CFP. 45° field of view. 2184 x 1690 pixels
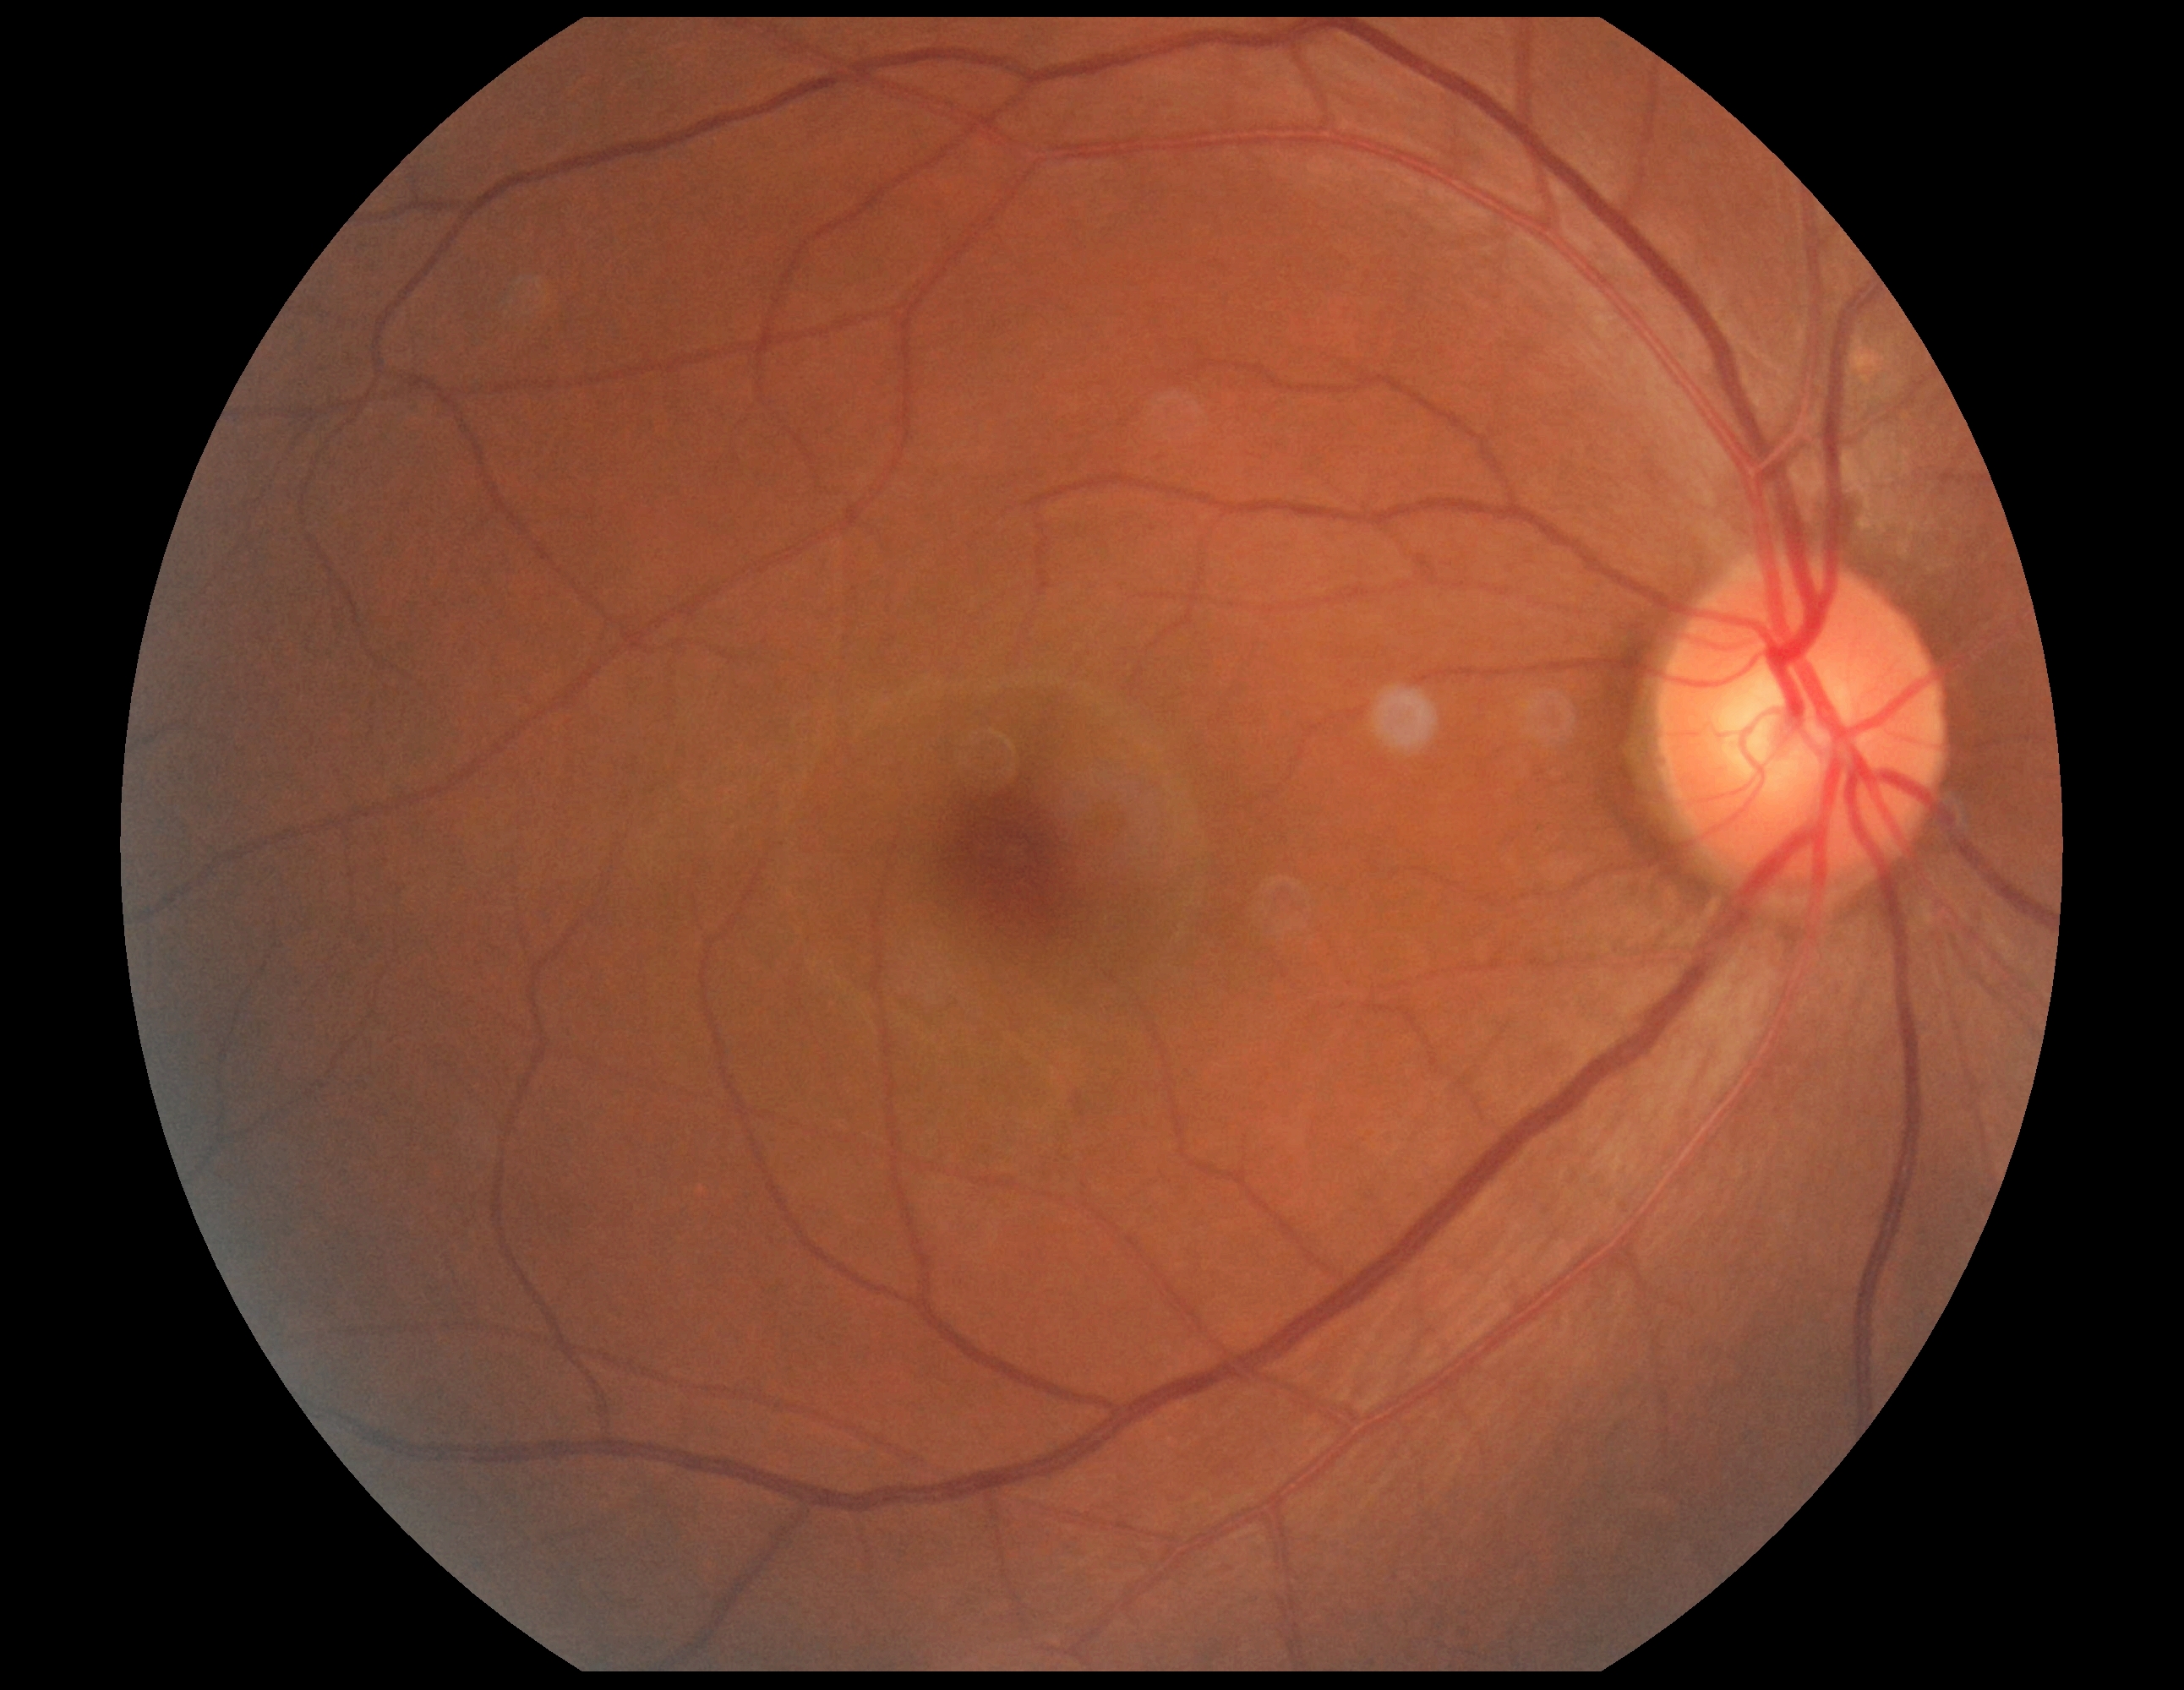

dr_grade: 0